1932x1932px.
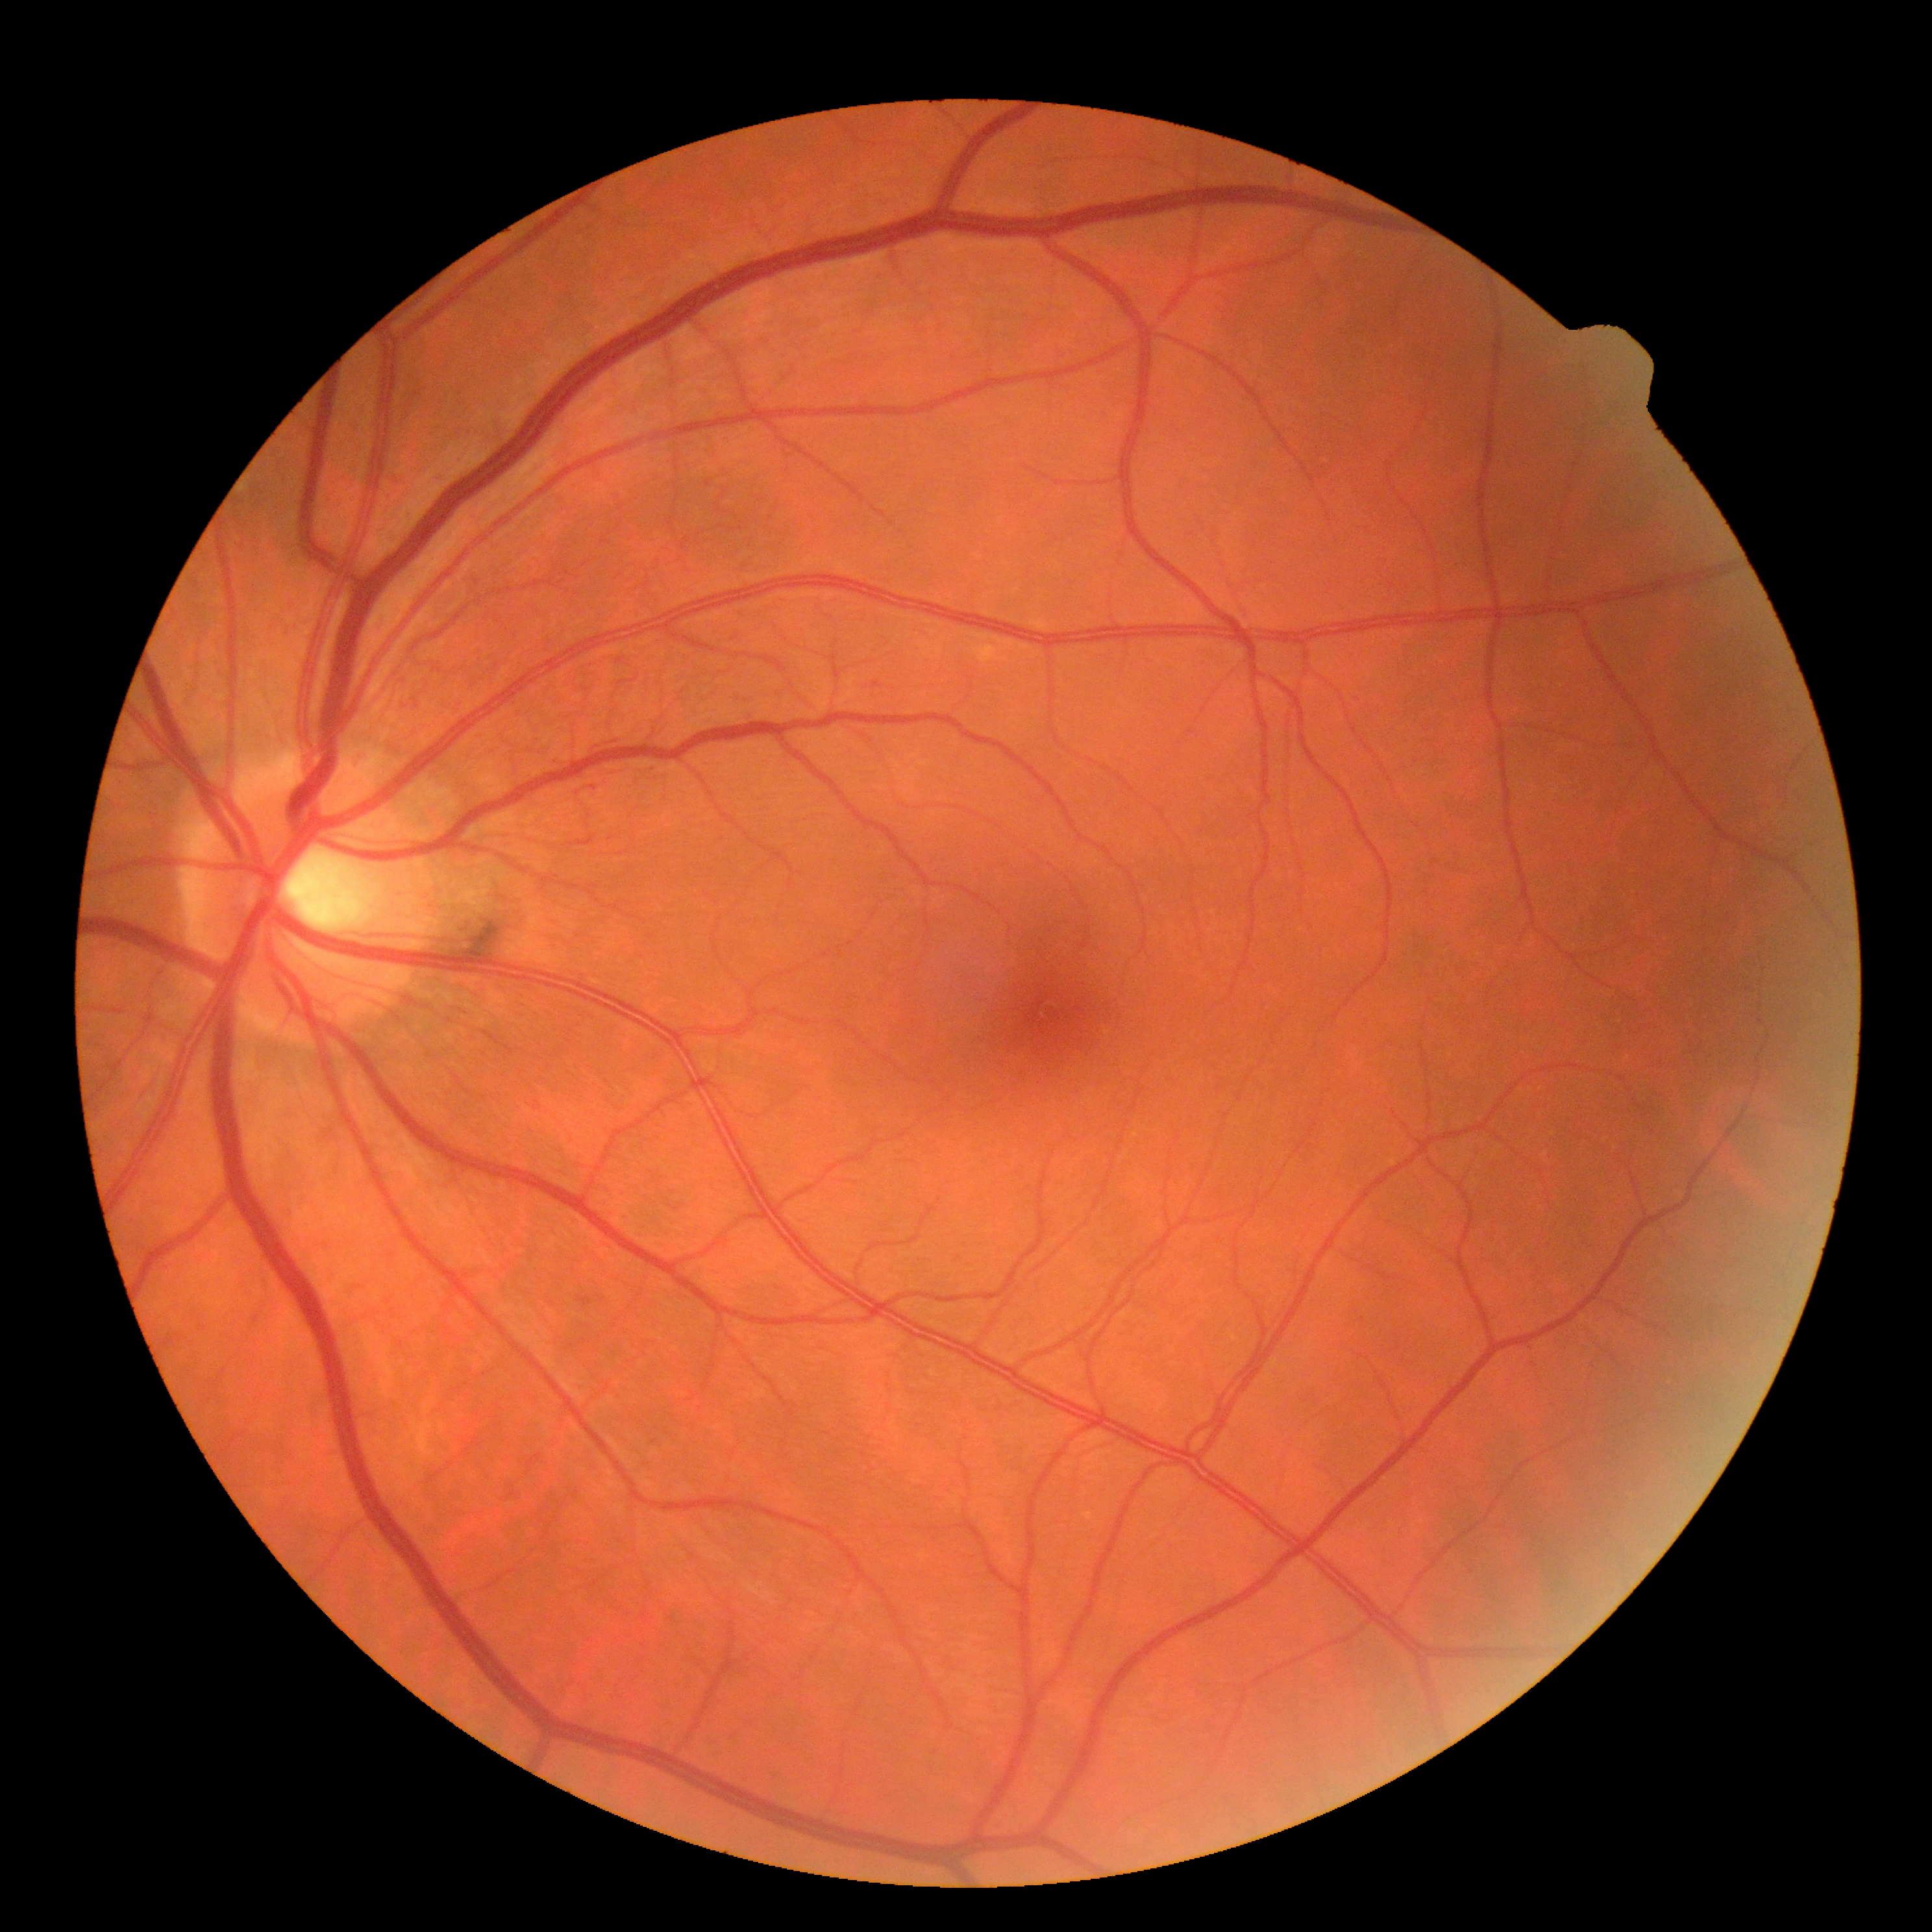

Diabetic retinopathy (DR): 0 — no visible signs of diabetic retinopathy.